45° FOV
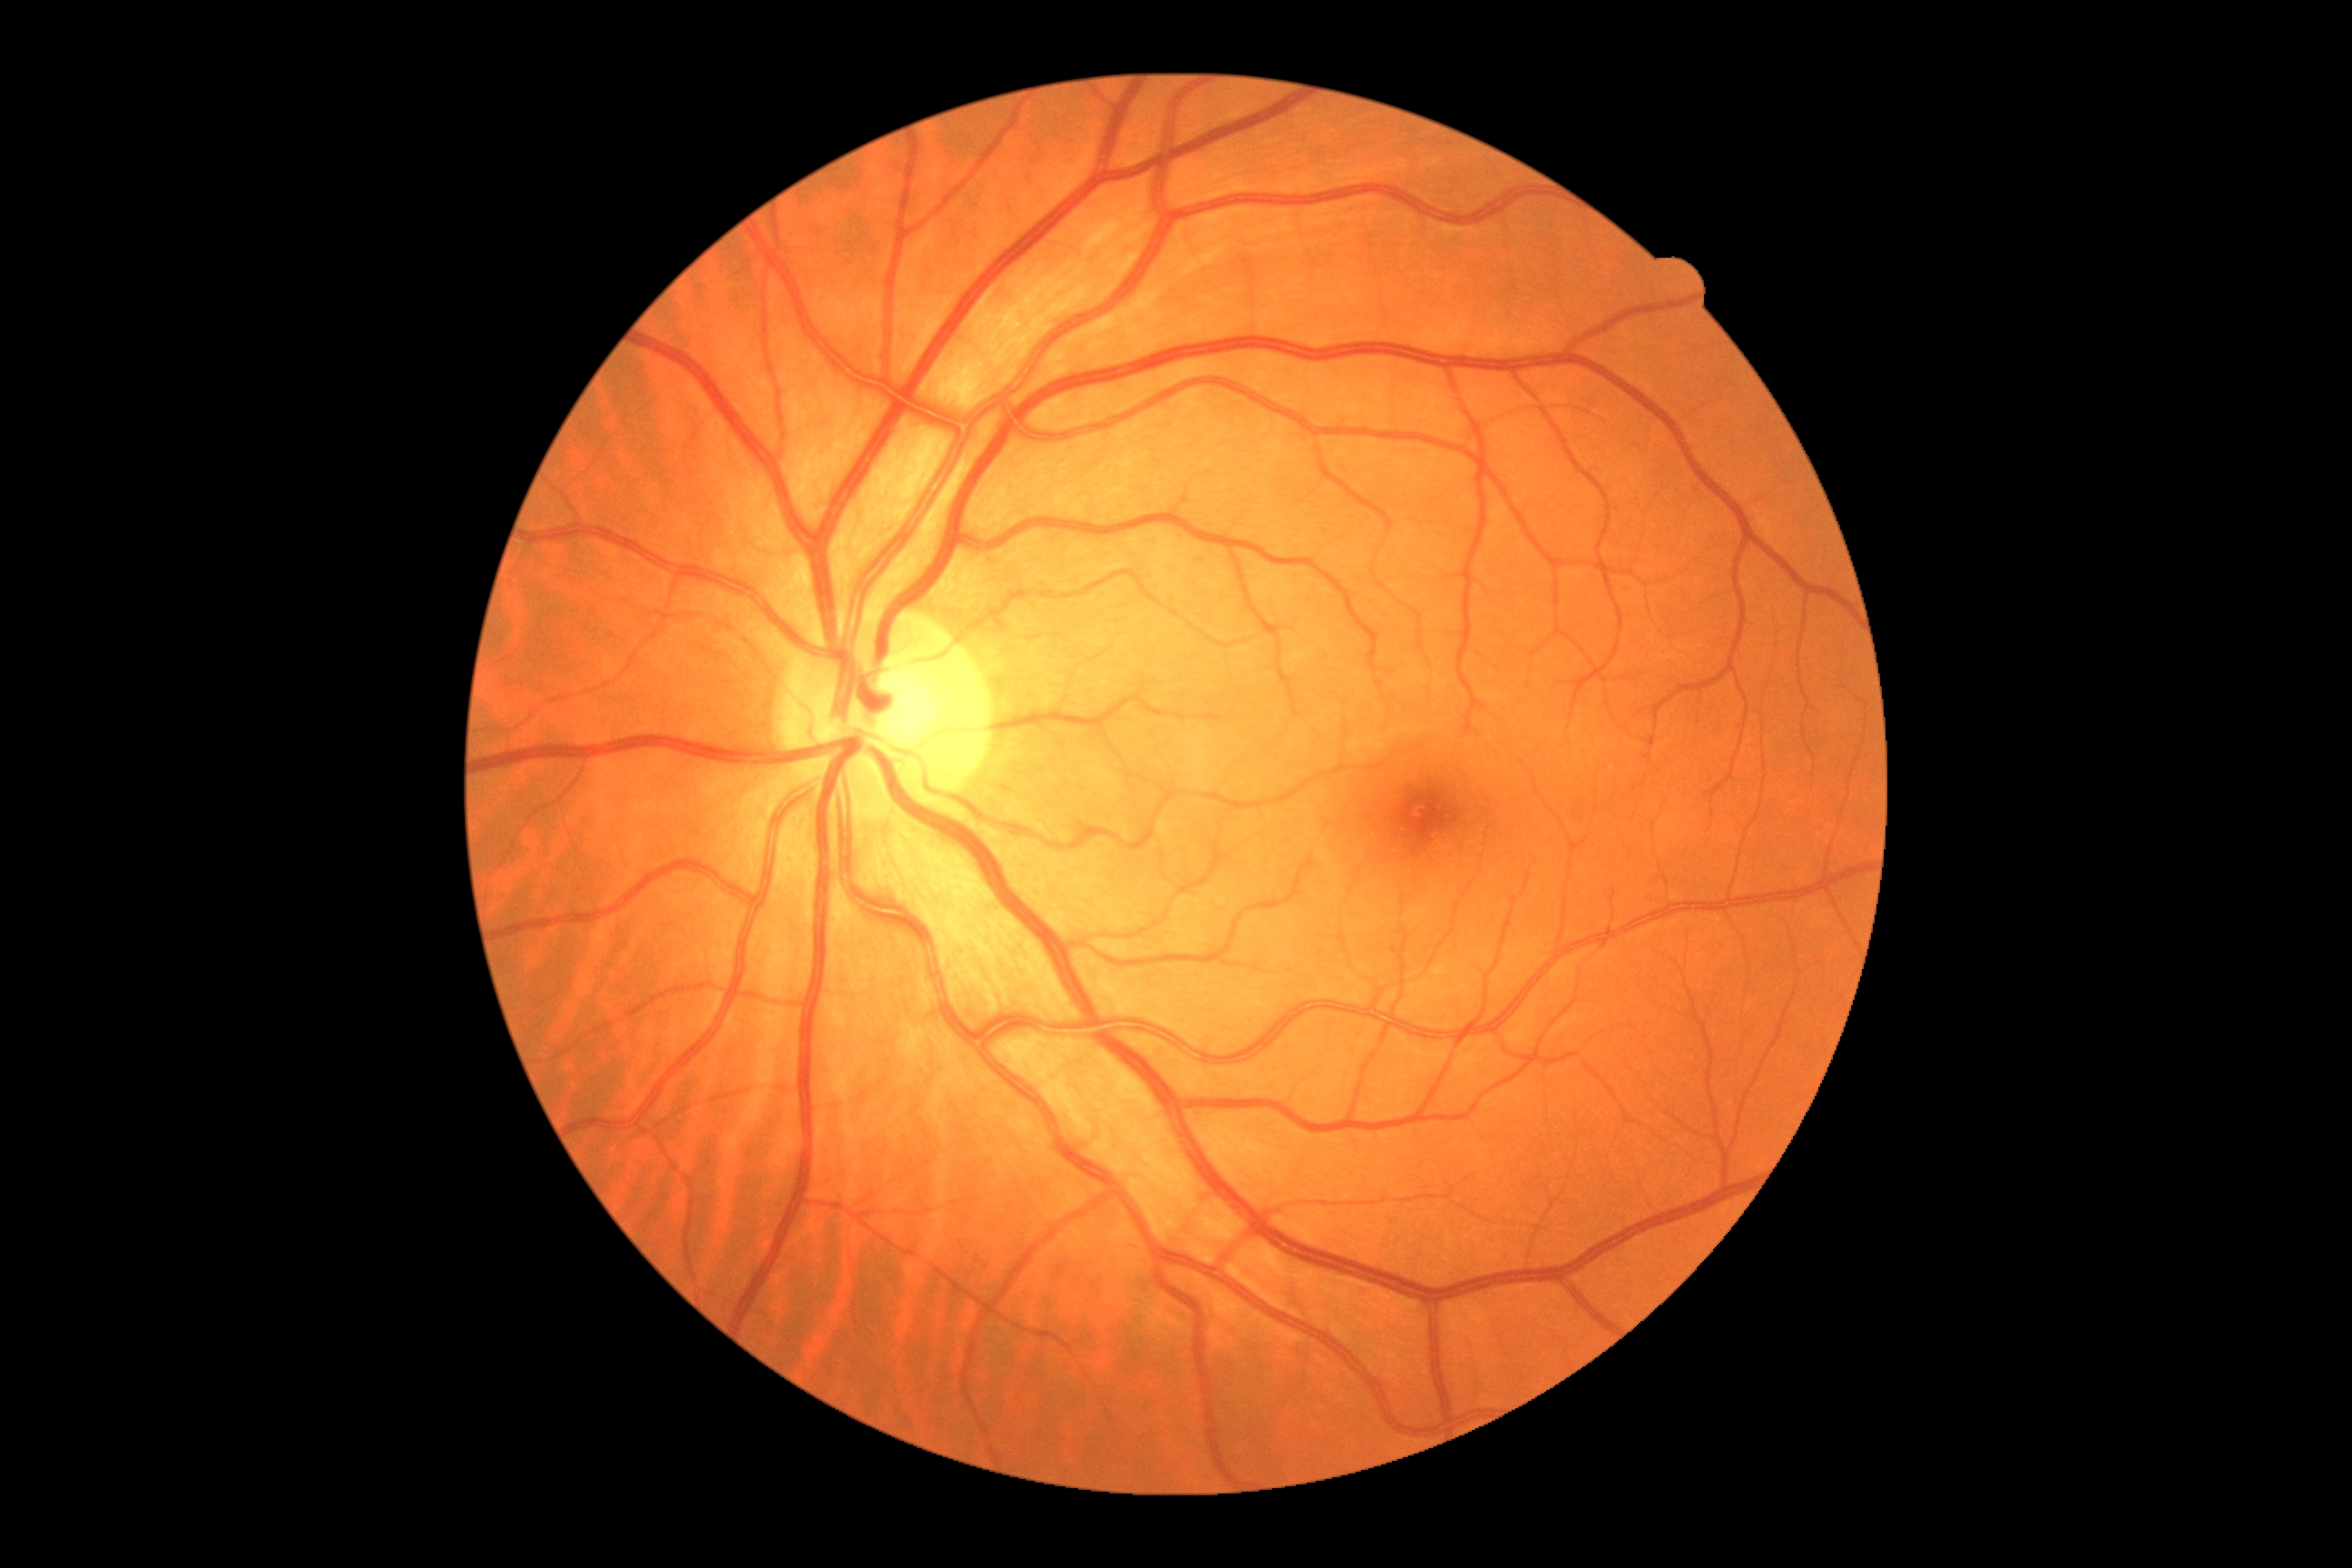 • DR — grade 0 (no apparent retinopathy)